Color fundus photograph, 1932 by 1932 pixels:
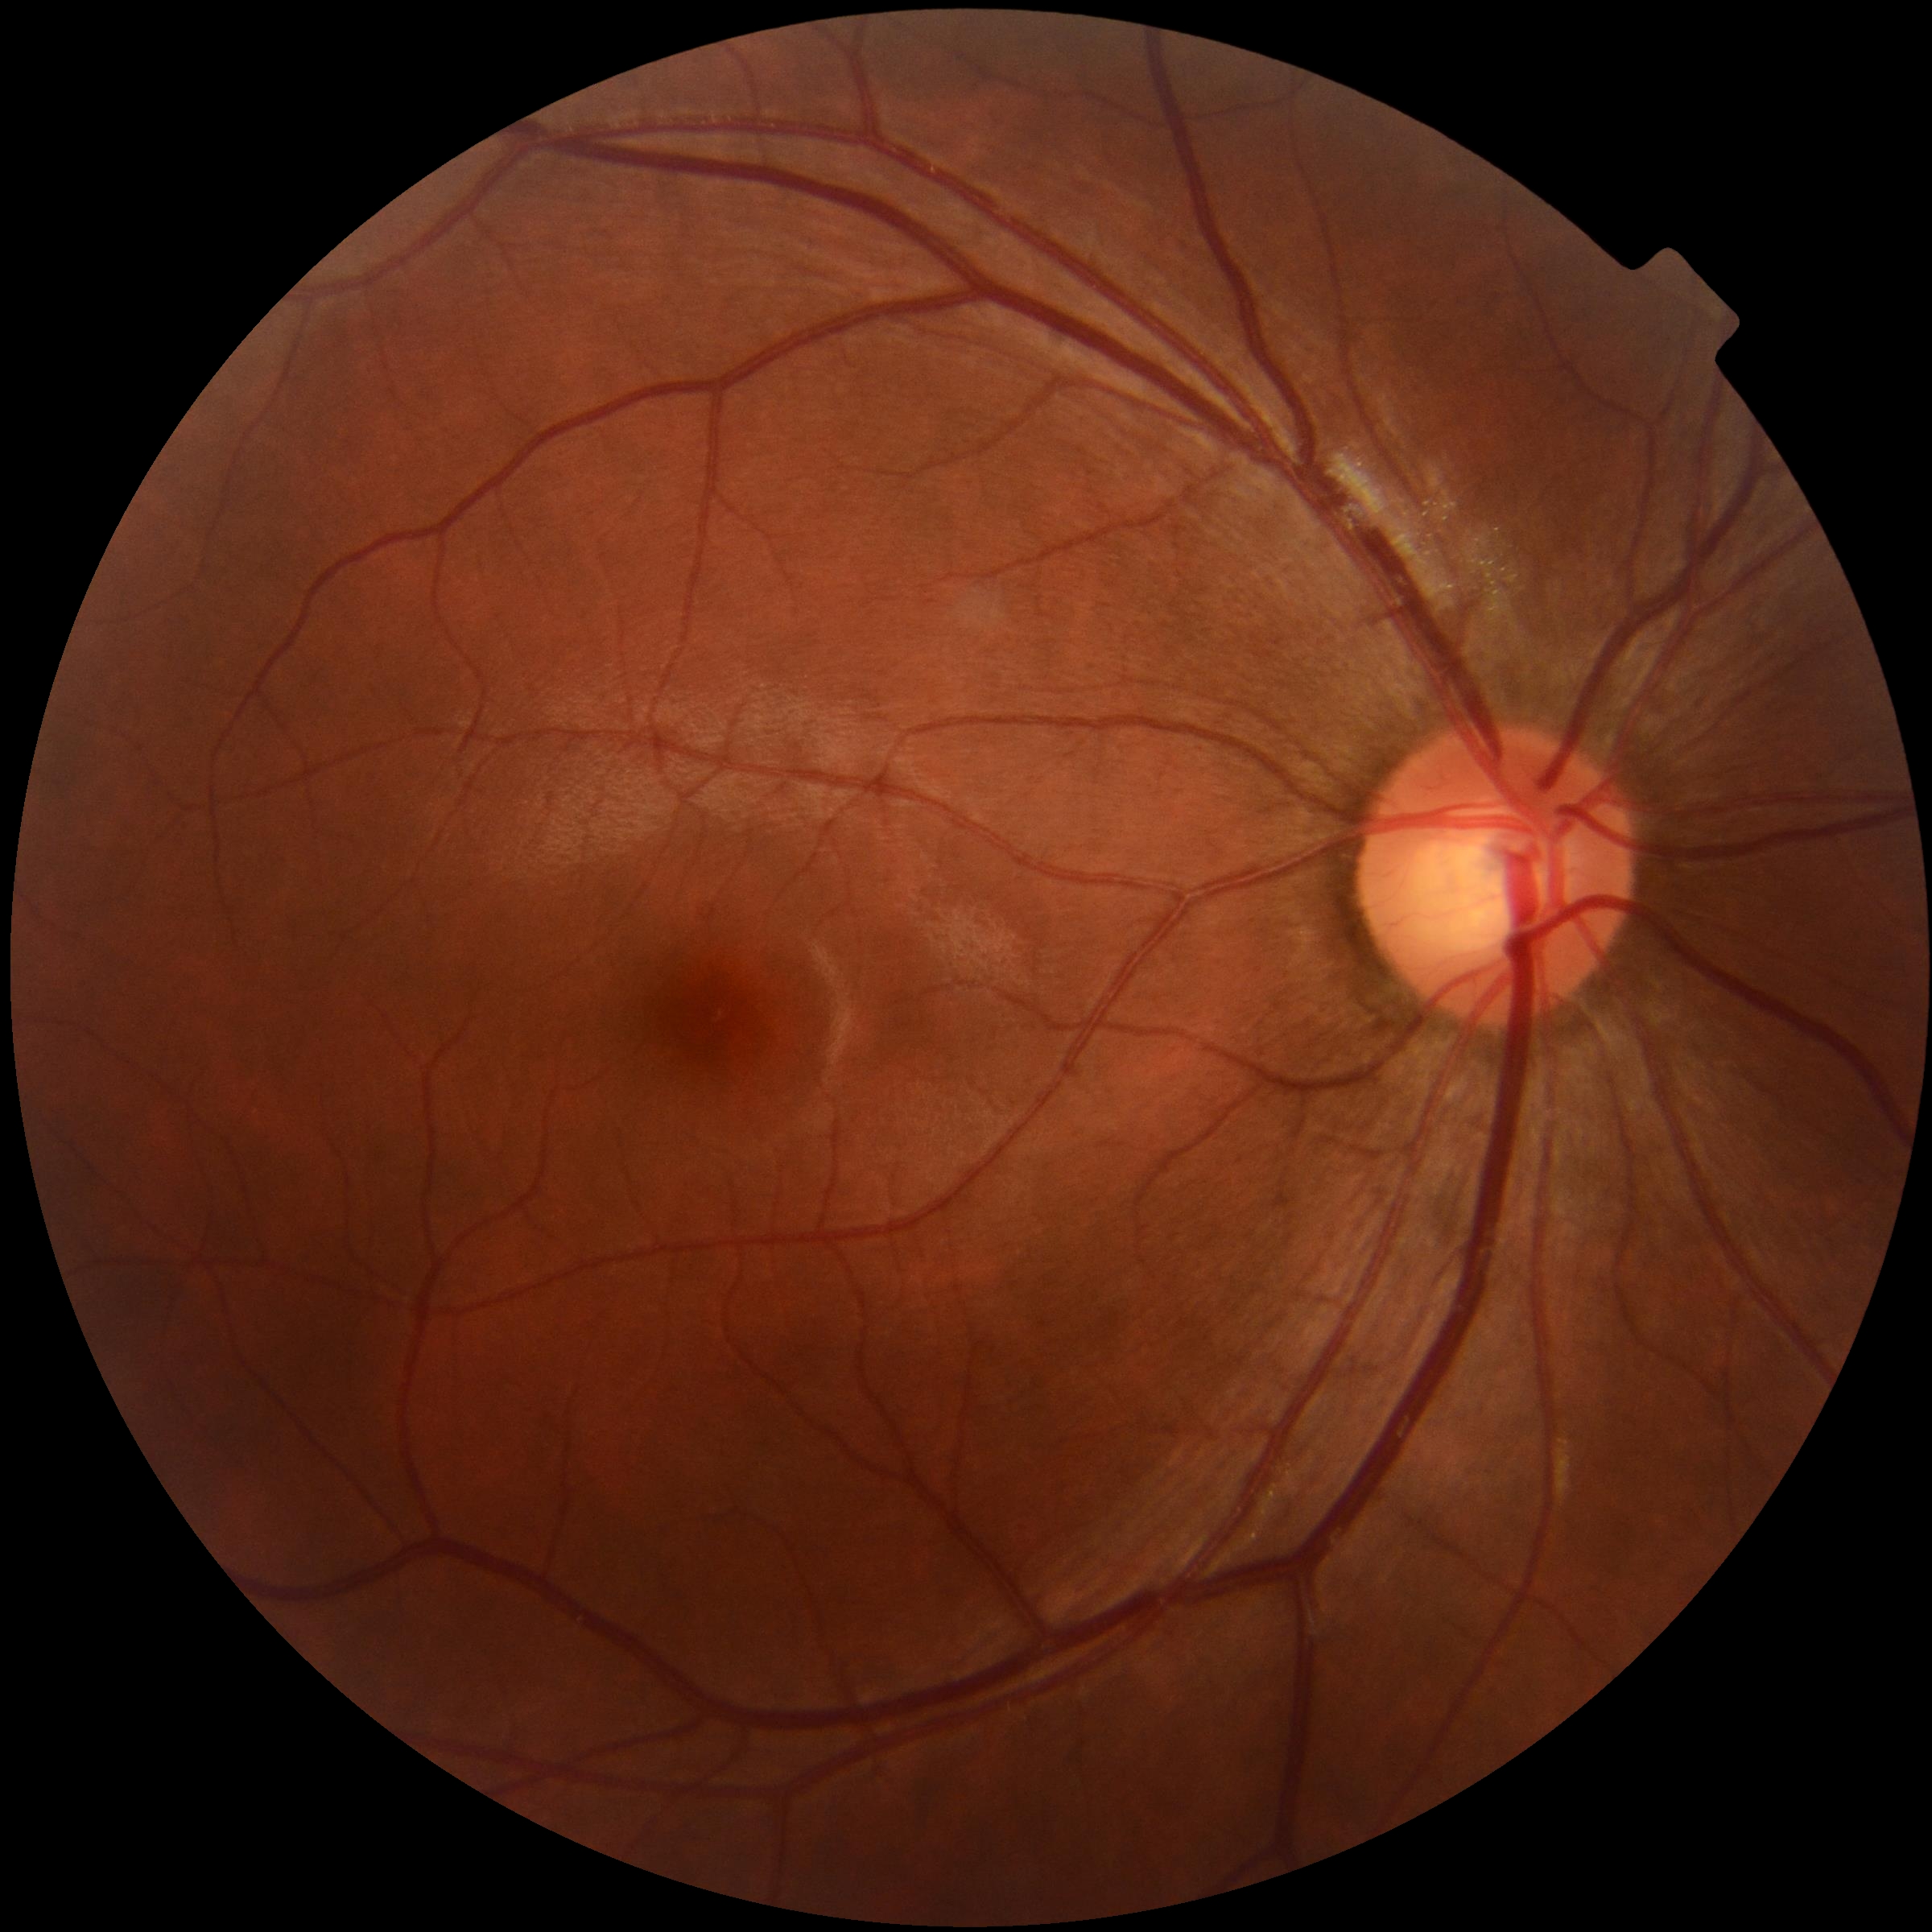

retinopathy: 0/4.